Camera: Natus RetCam Envision (130° FOV) · infant wide-field retinal image:
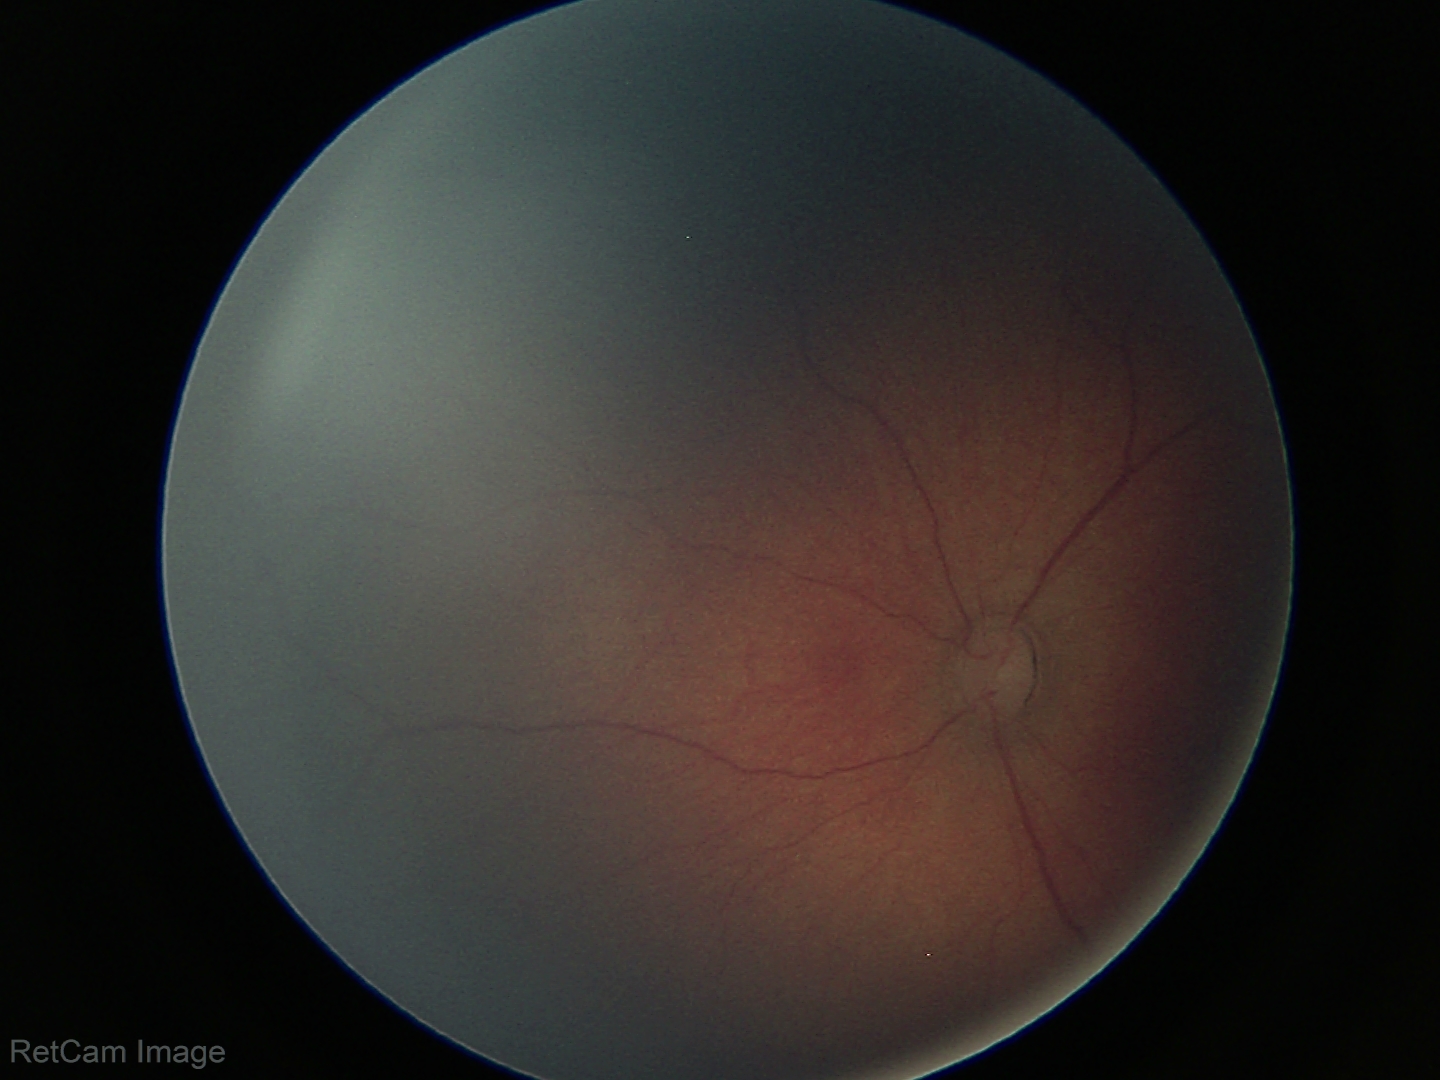 Screening series with ROP stage 2.